Acquired on the Clarity RetCam 3; image size 640x480; wide-field fundus photograph of an infant: 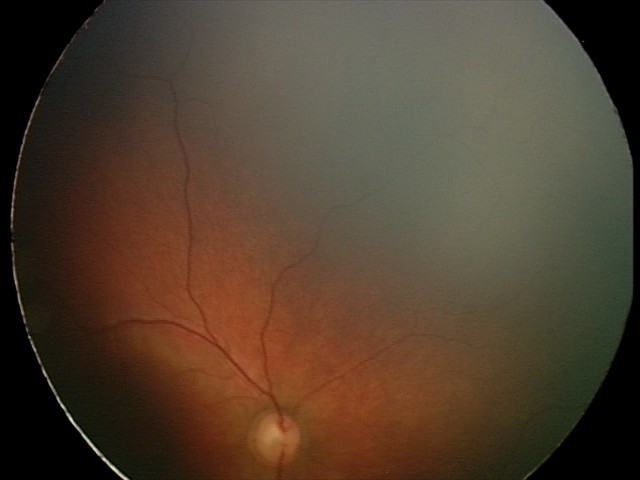
Diagnosis: physiological.